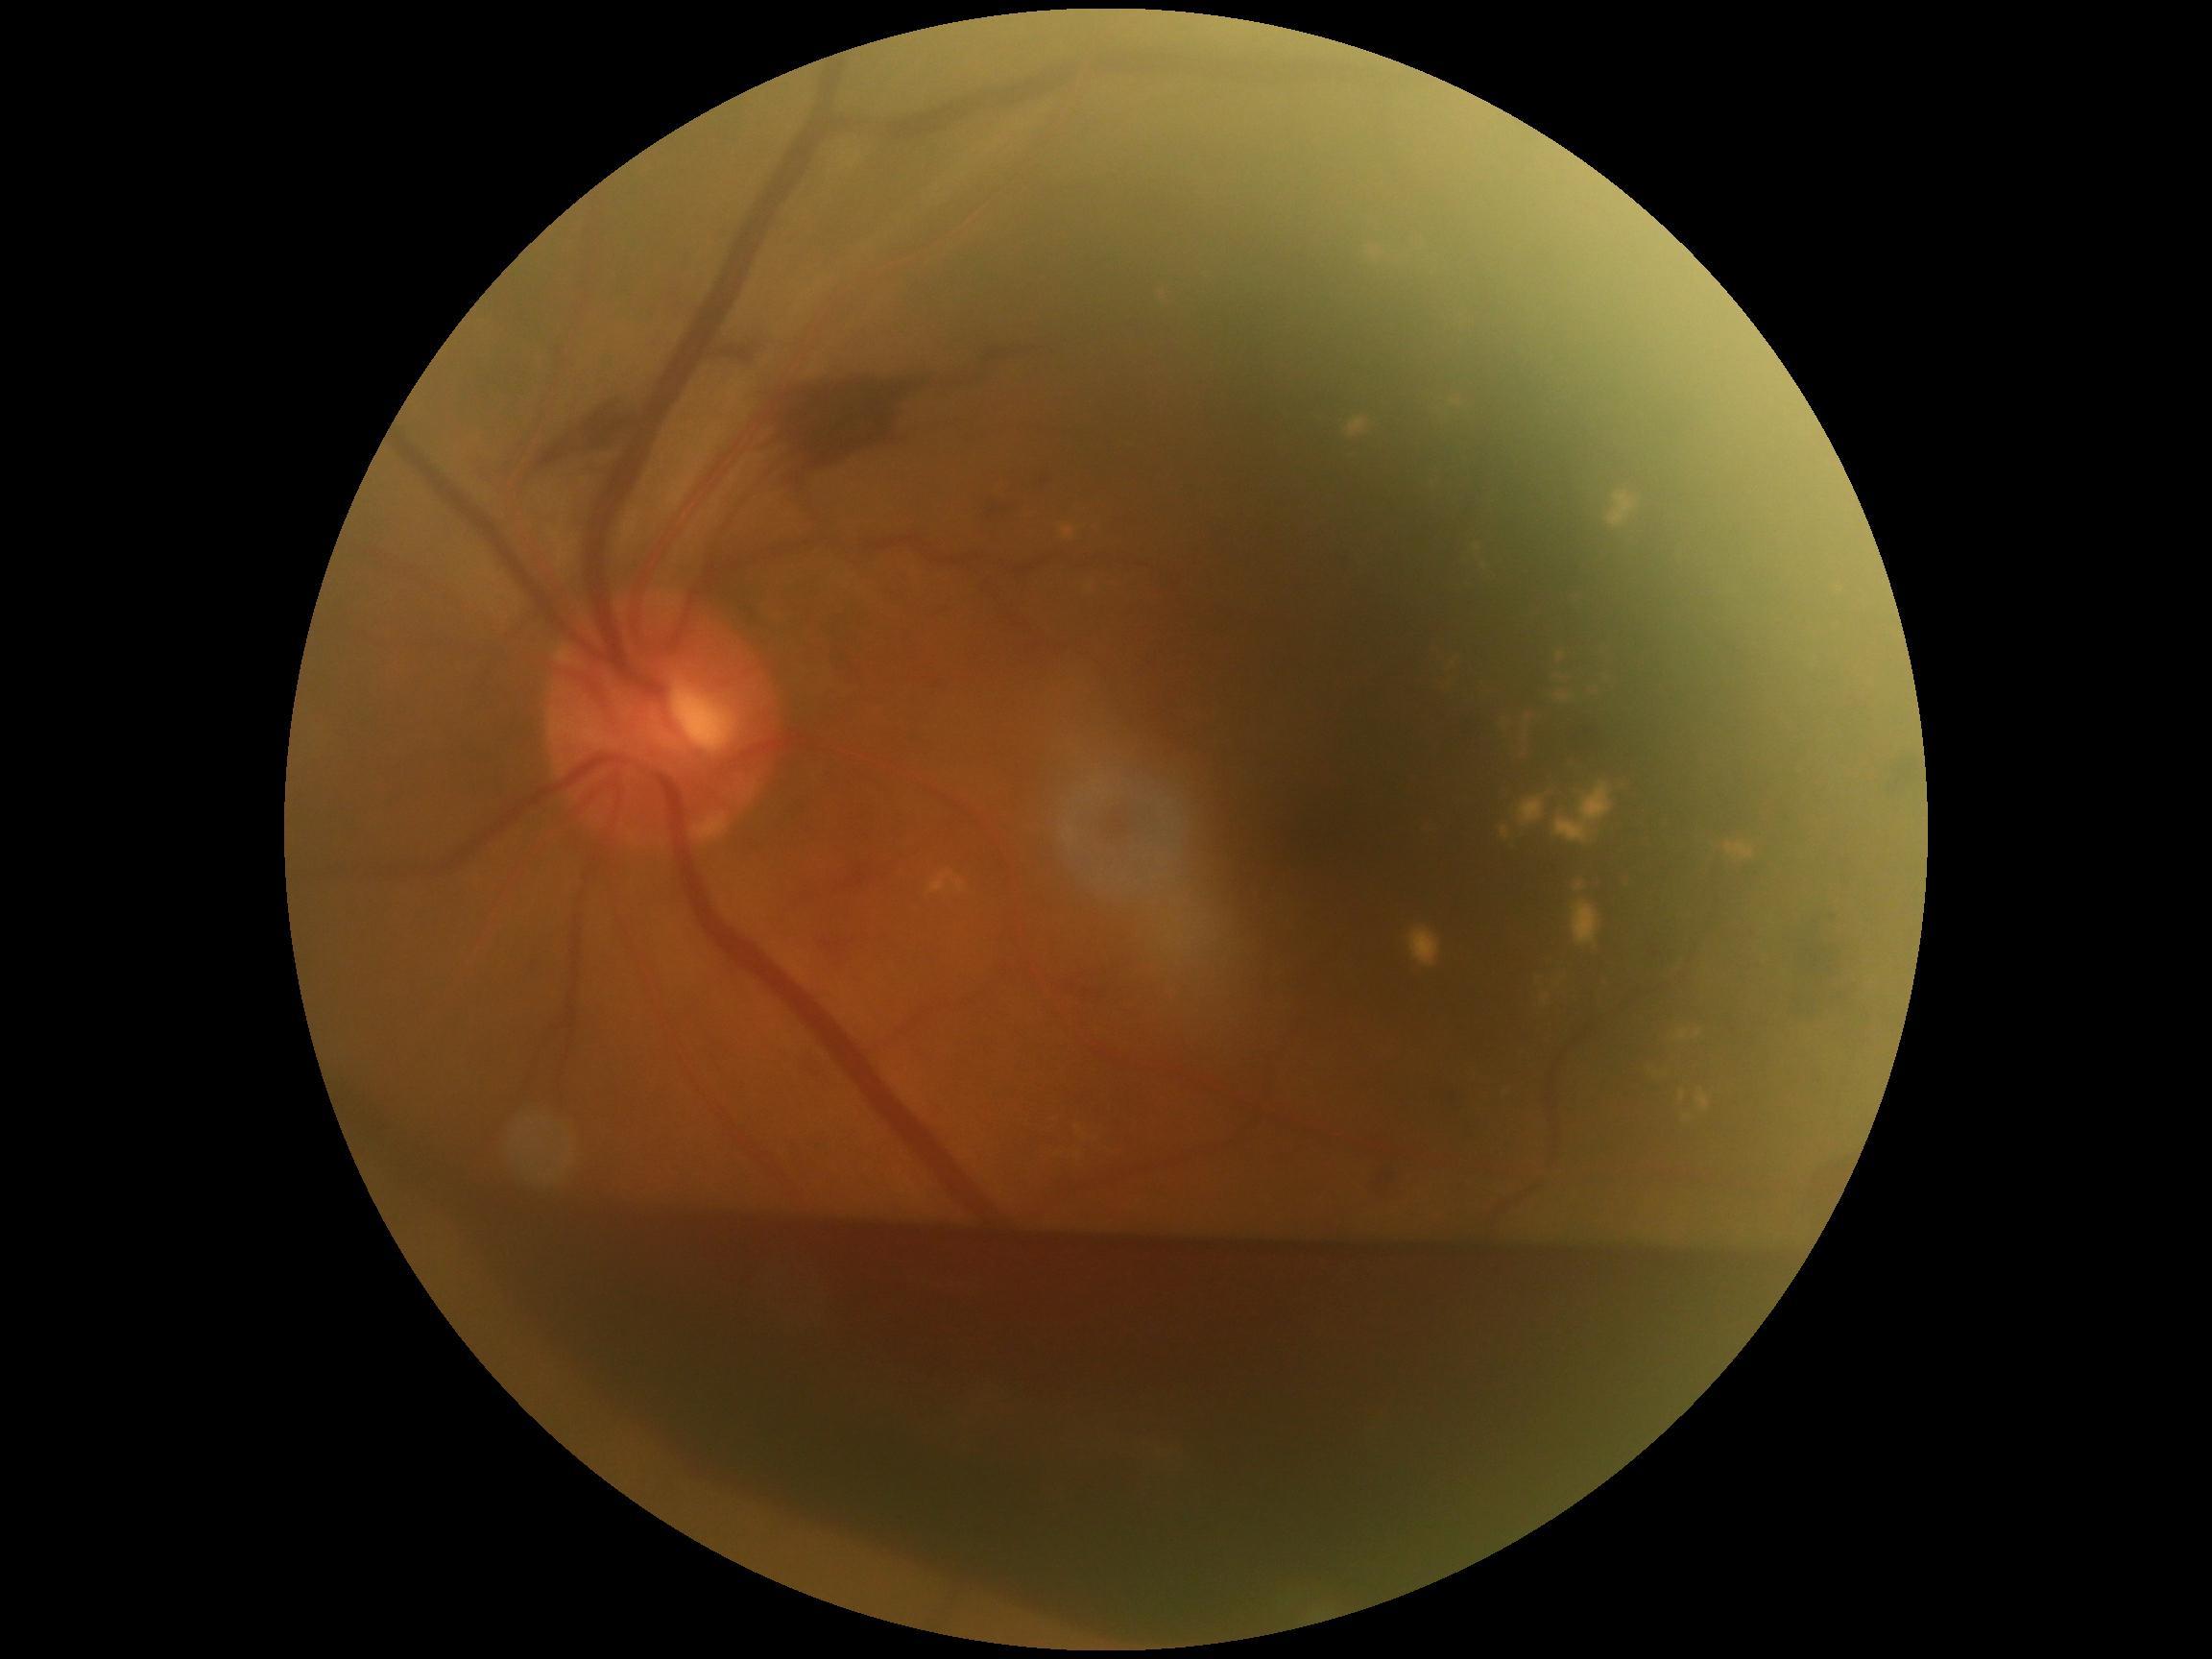

Annotations:
• diabetic retinopathy severity: grade 4 (PDR)